Color fundus photograph from a handheld portable camera.
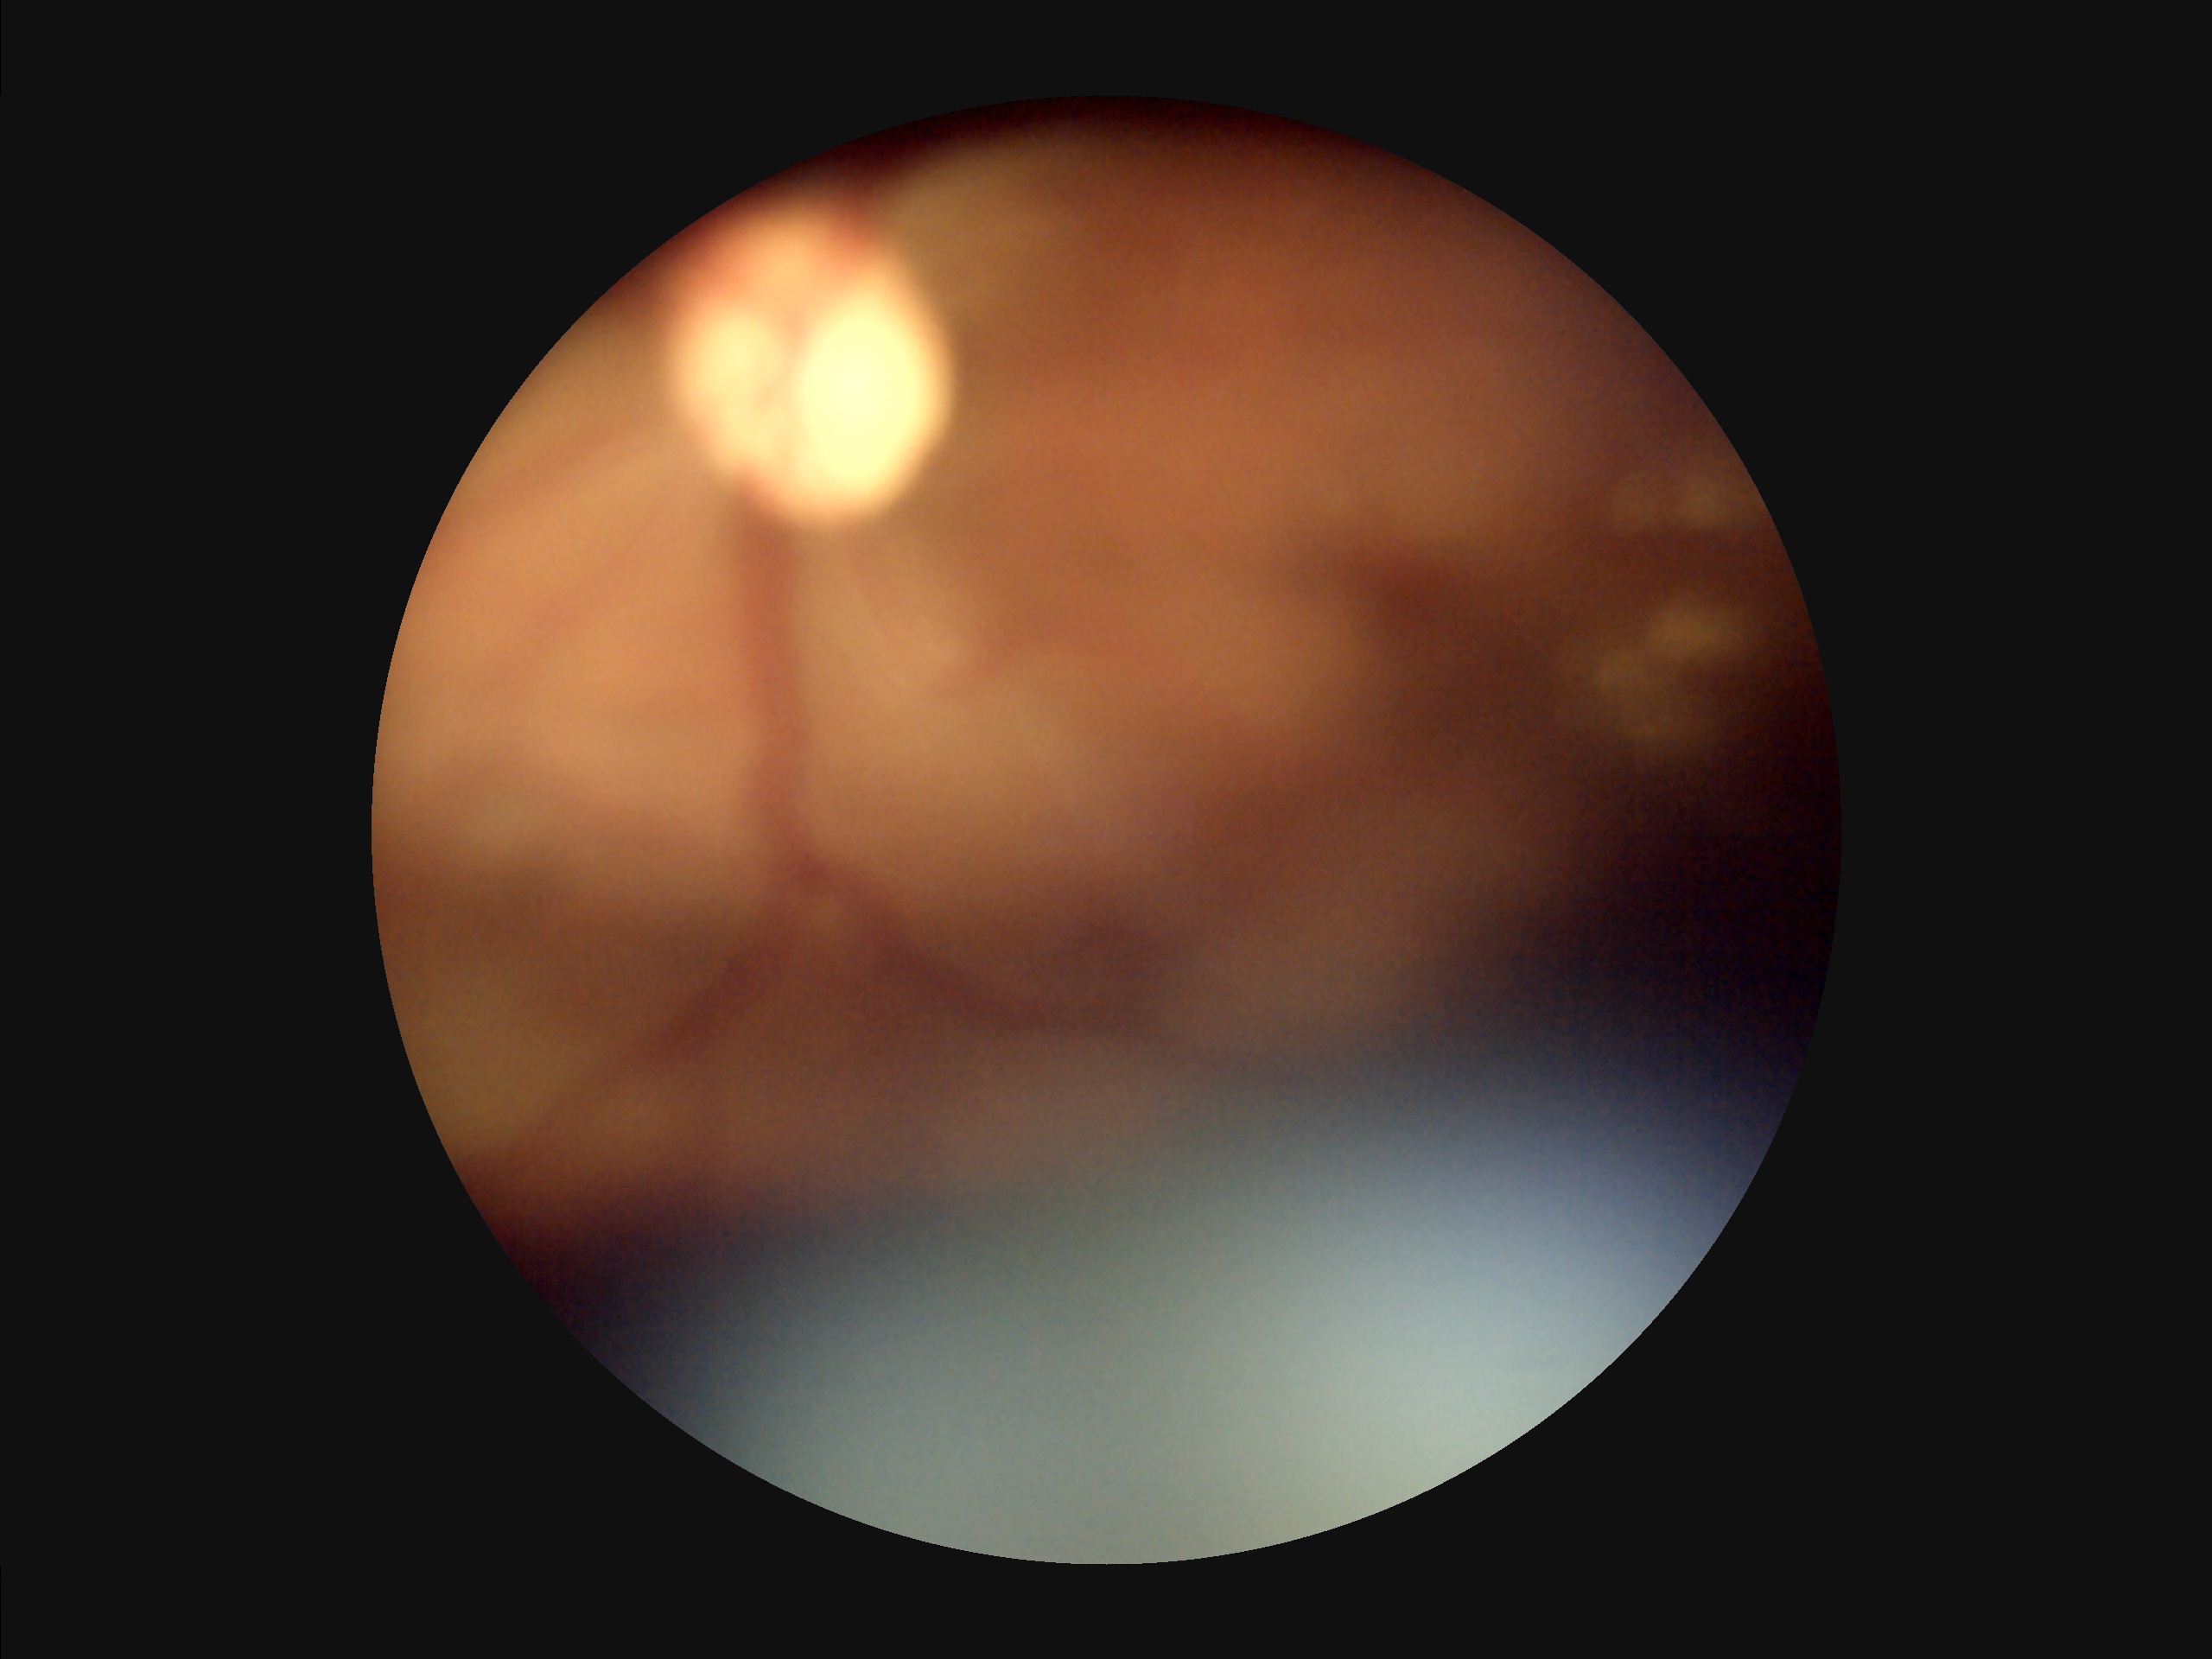

Overall image quality = inadequate
Illumination = poor
Sharpness = blurry
Contrast = low